RetCam wide-field infant fundus image · captured with the Clarity RetCam 3 (130° field of view) · 640x480px:
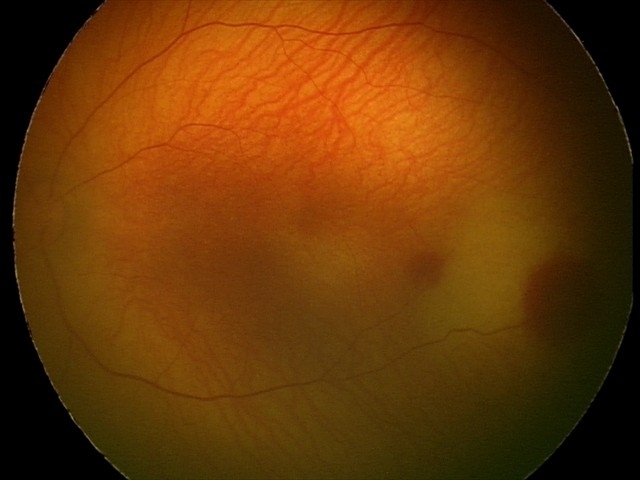

Screening examination consistent with retinal hemorrhages.